Pediatric retinal photograph (wide-field); 640x480: 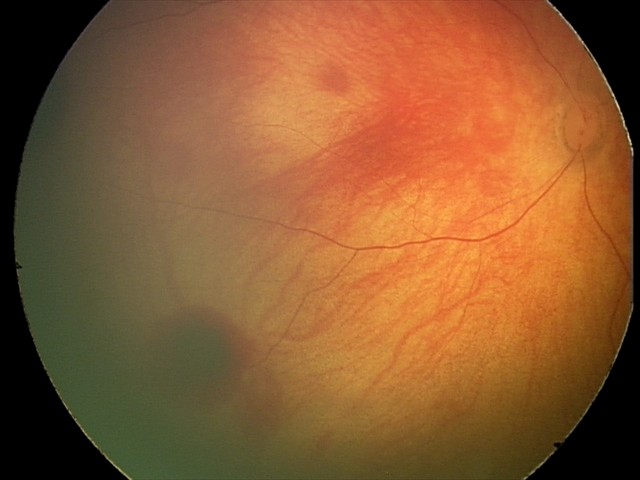
Impression: retinal hemorrhages.